100° field of view (Phoenix ICON). Pediatric retinal photograph (wide-field). 1240 by 1240 pixels:
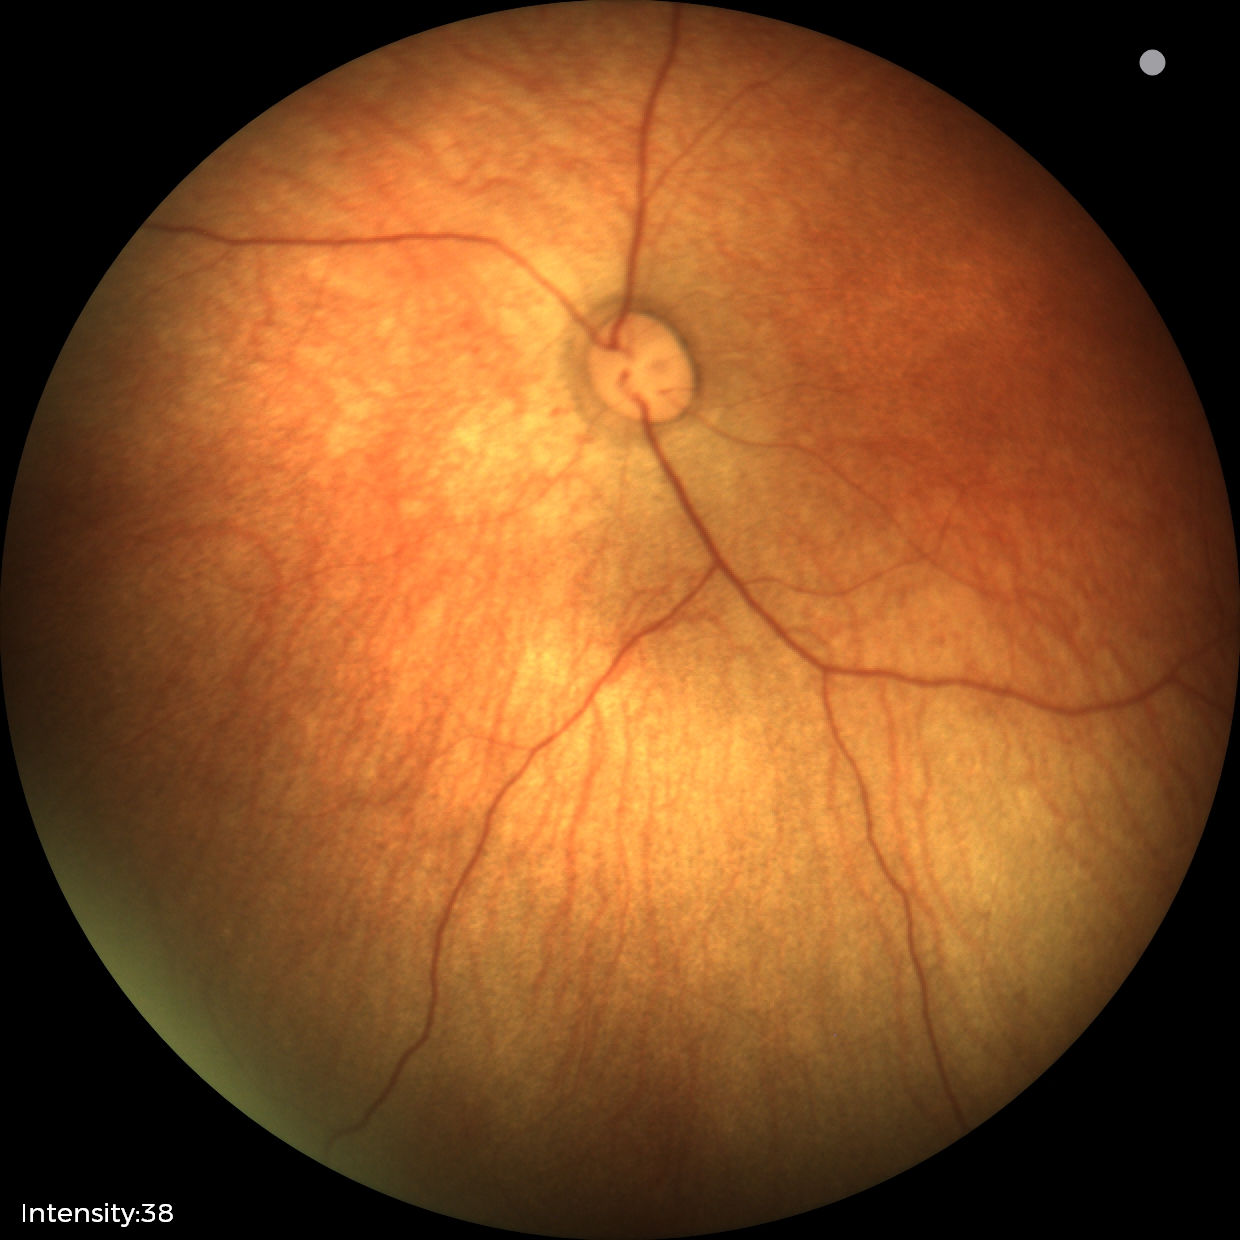 Screening examination with no abnormal retinal findings.